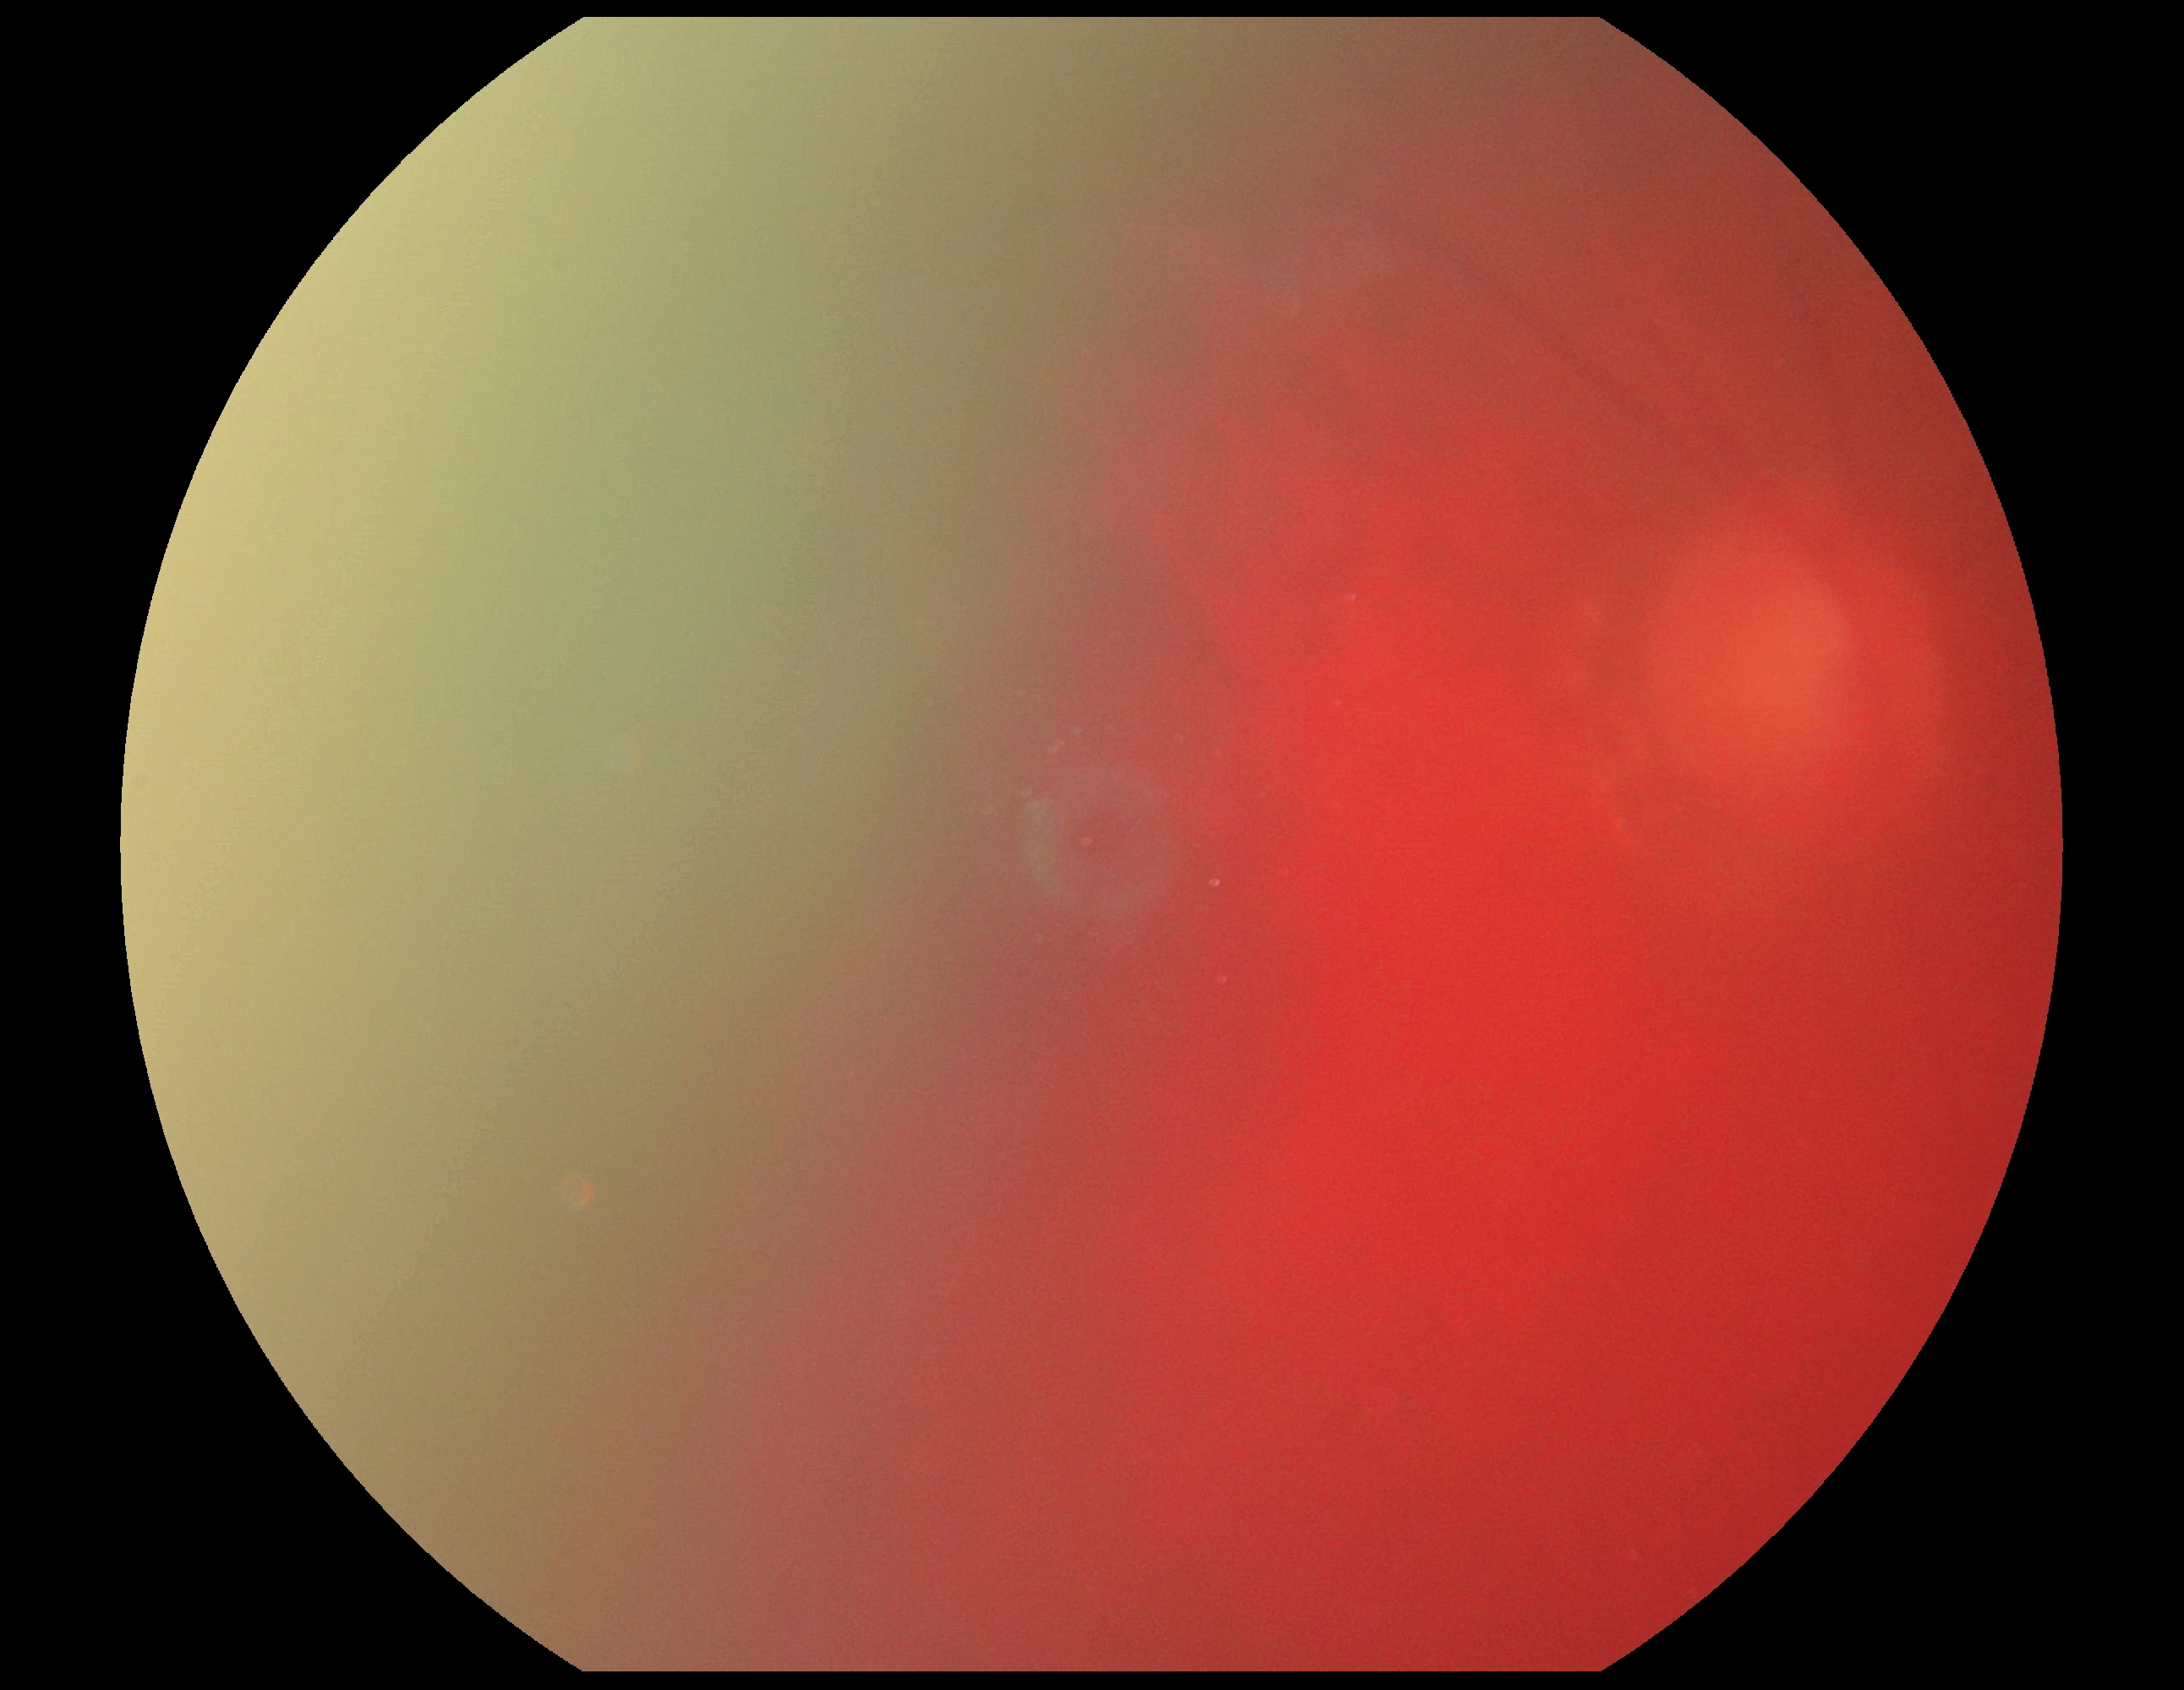
{
  "dr_grade": "ungradable due to poor image quality"
}